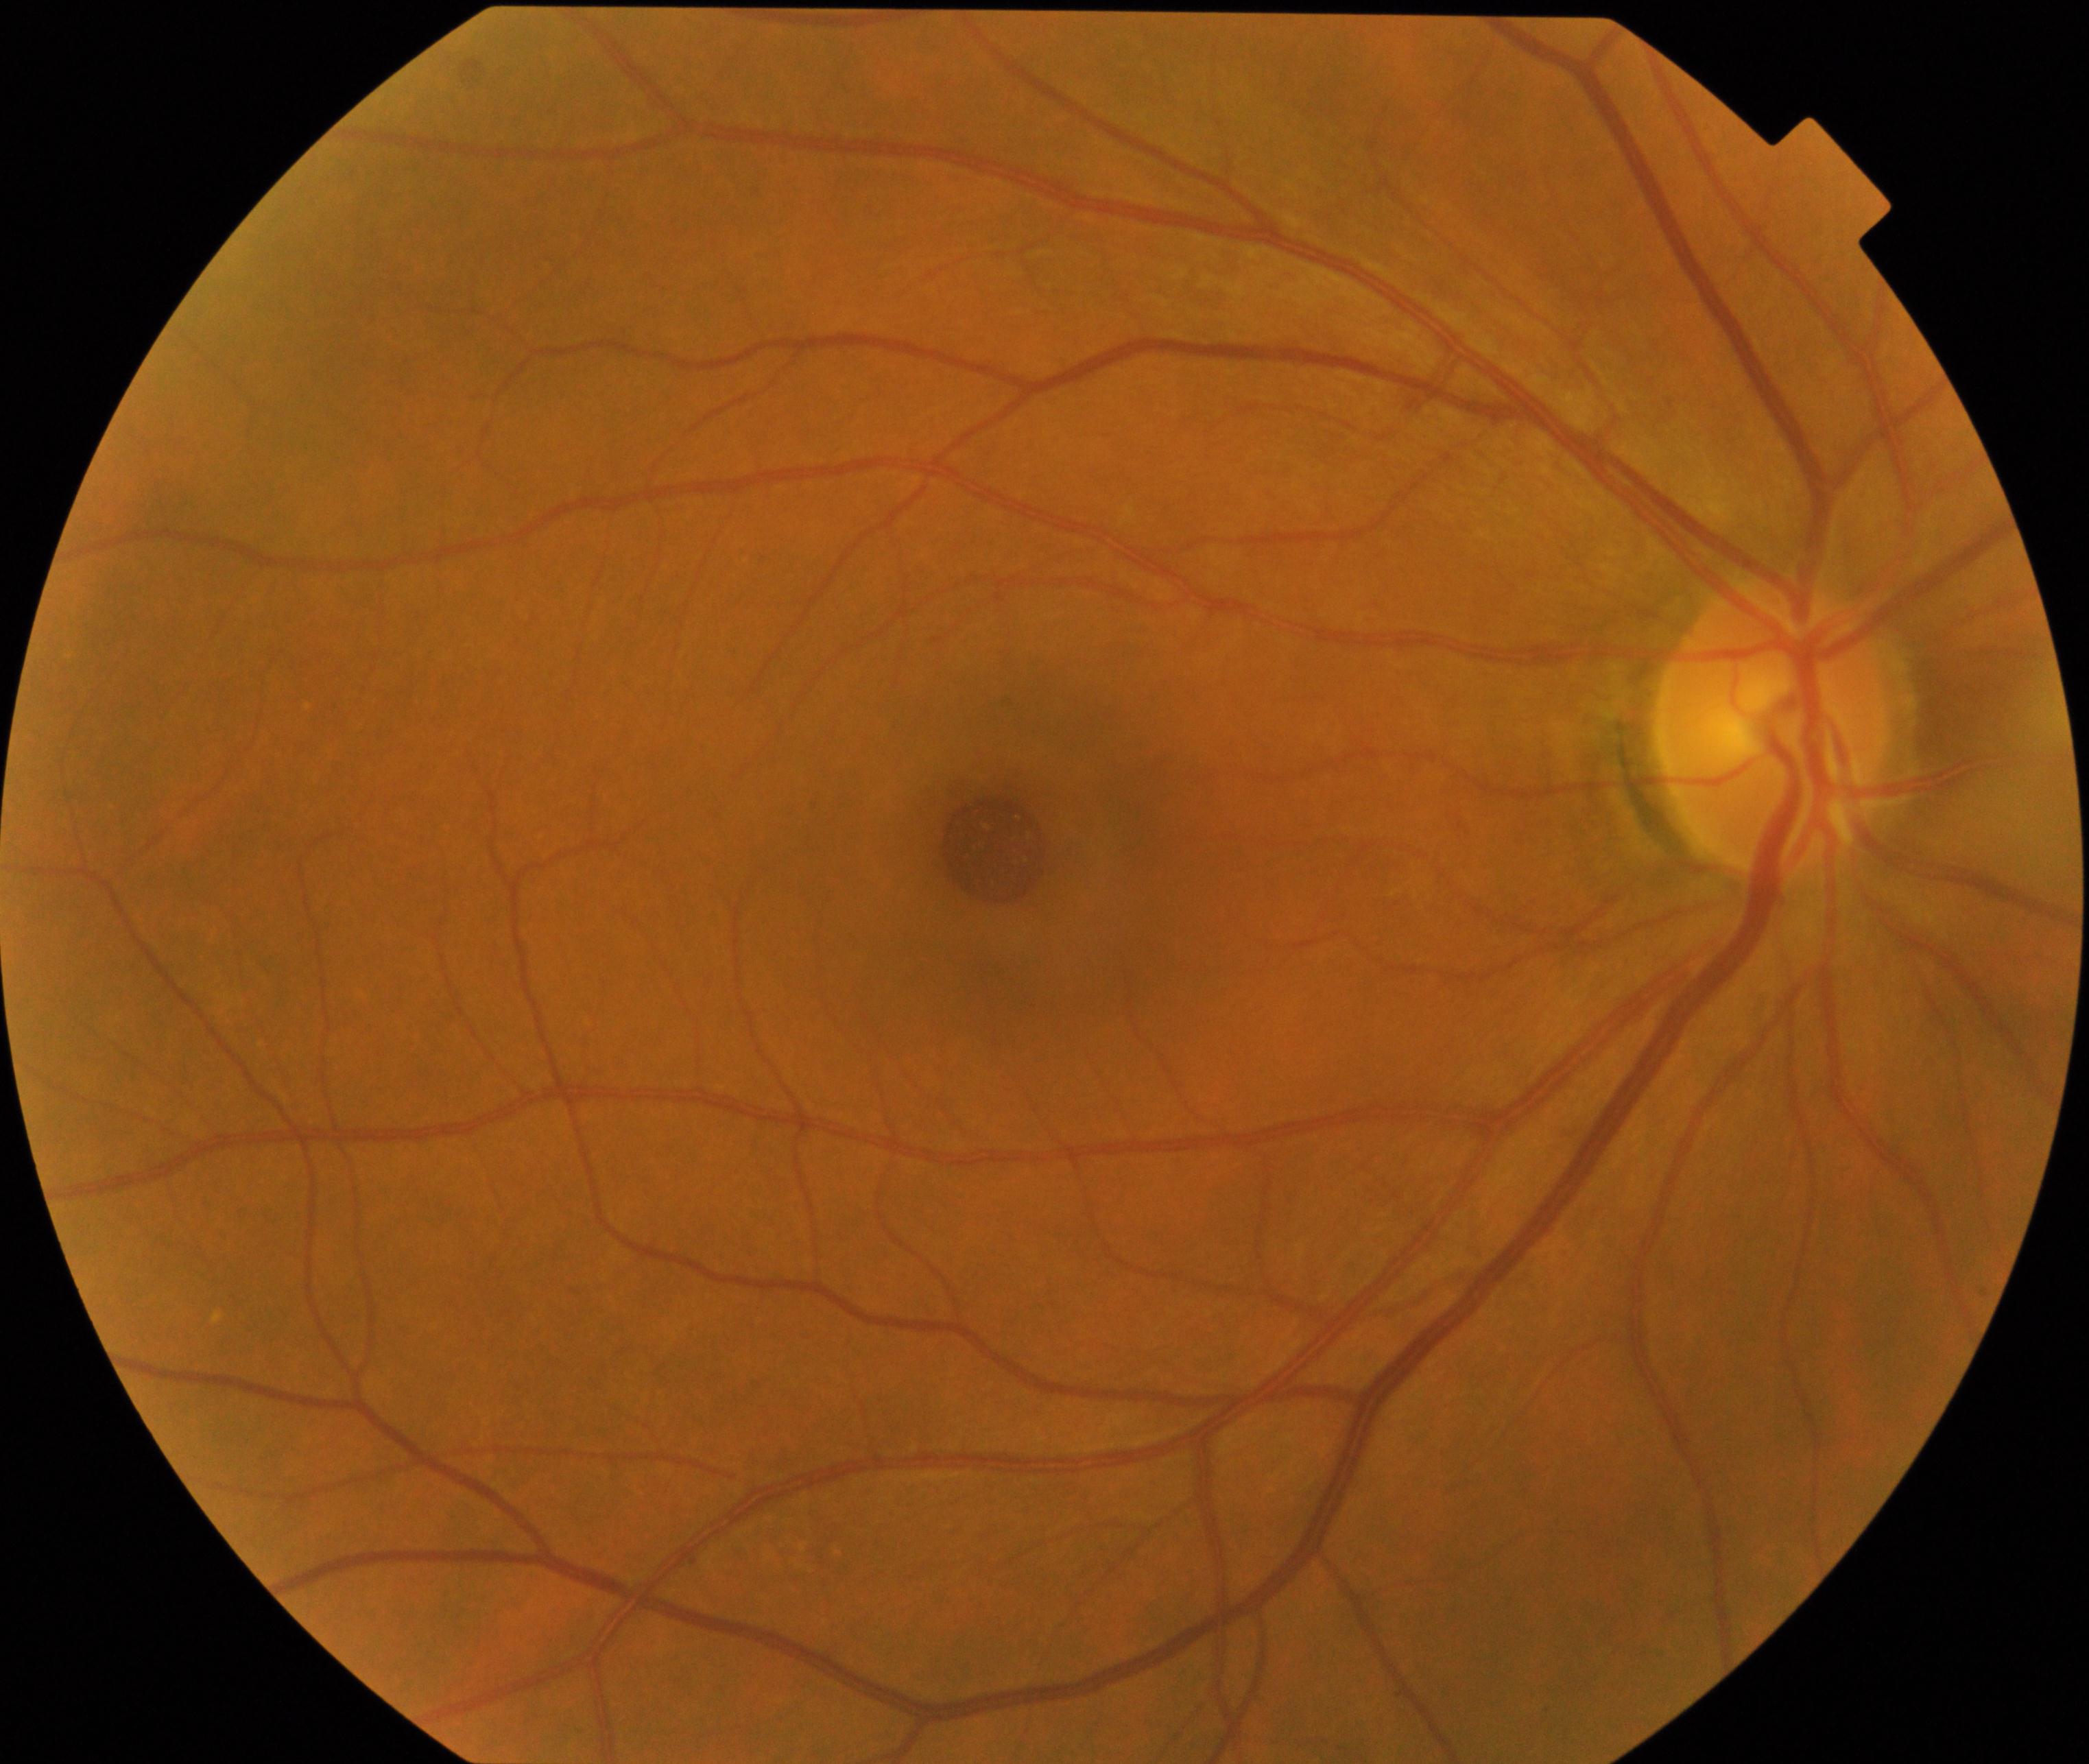 Findings: macular hole.